Infant wide-field retinal image.
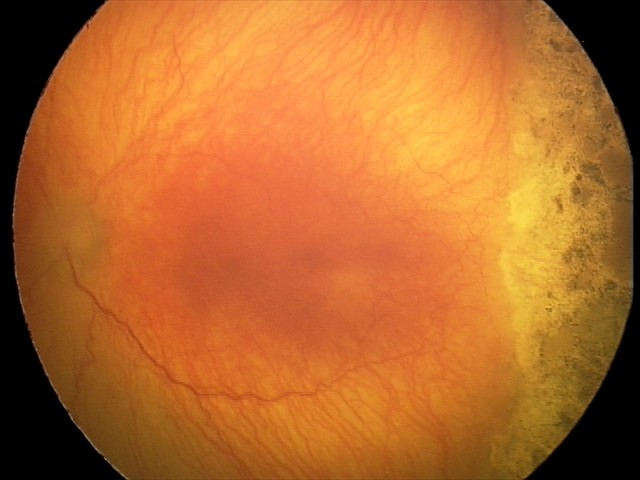

With plus disease. Screening series with aggressive retinopathy of prematurity.